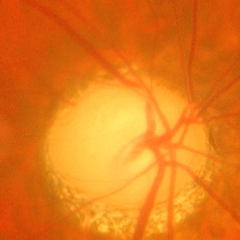
Advanced glaucoma.